Color fundus image; non-mydriatic fundus camera; centered on the optic disc.
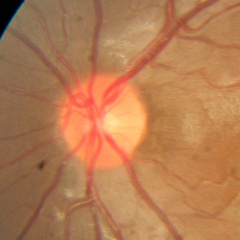 There is evidence of no glaucomatous optic neuropathy.